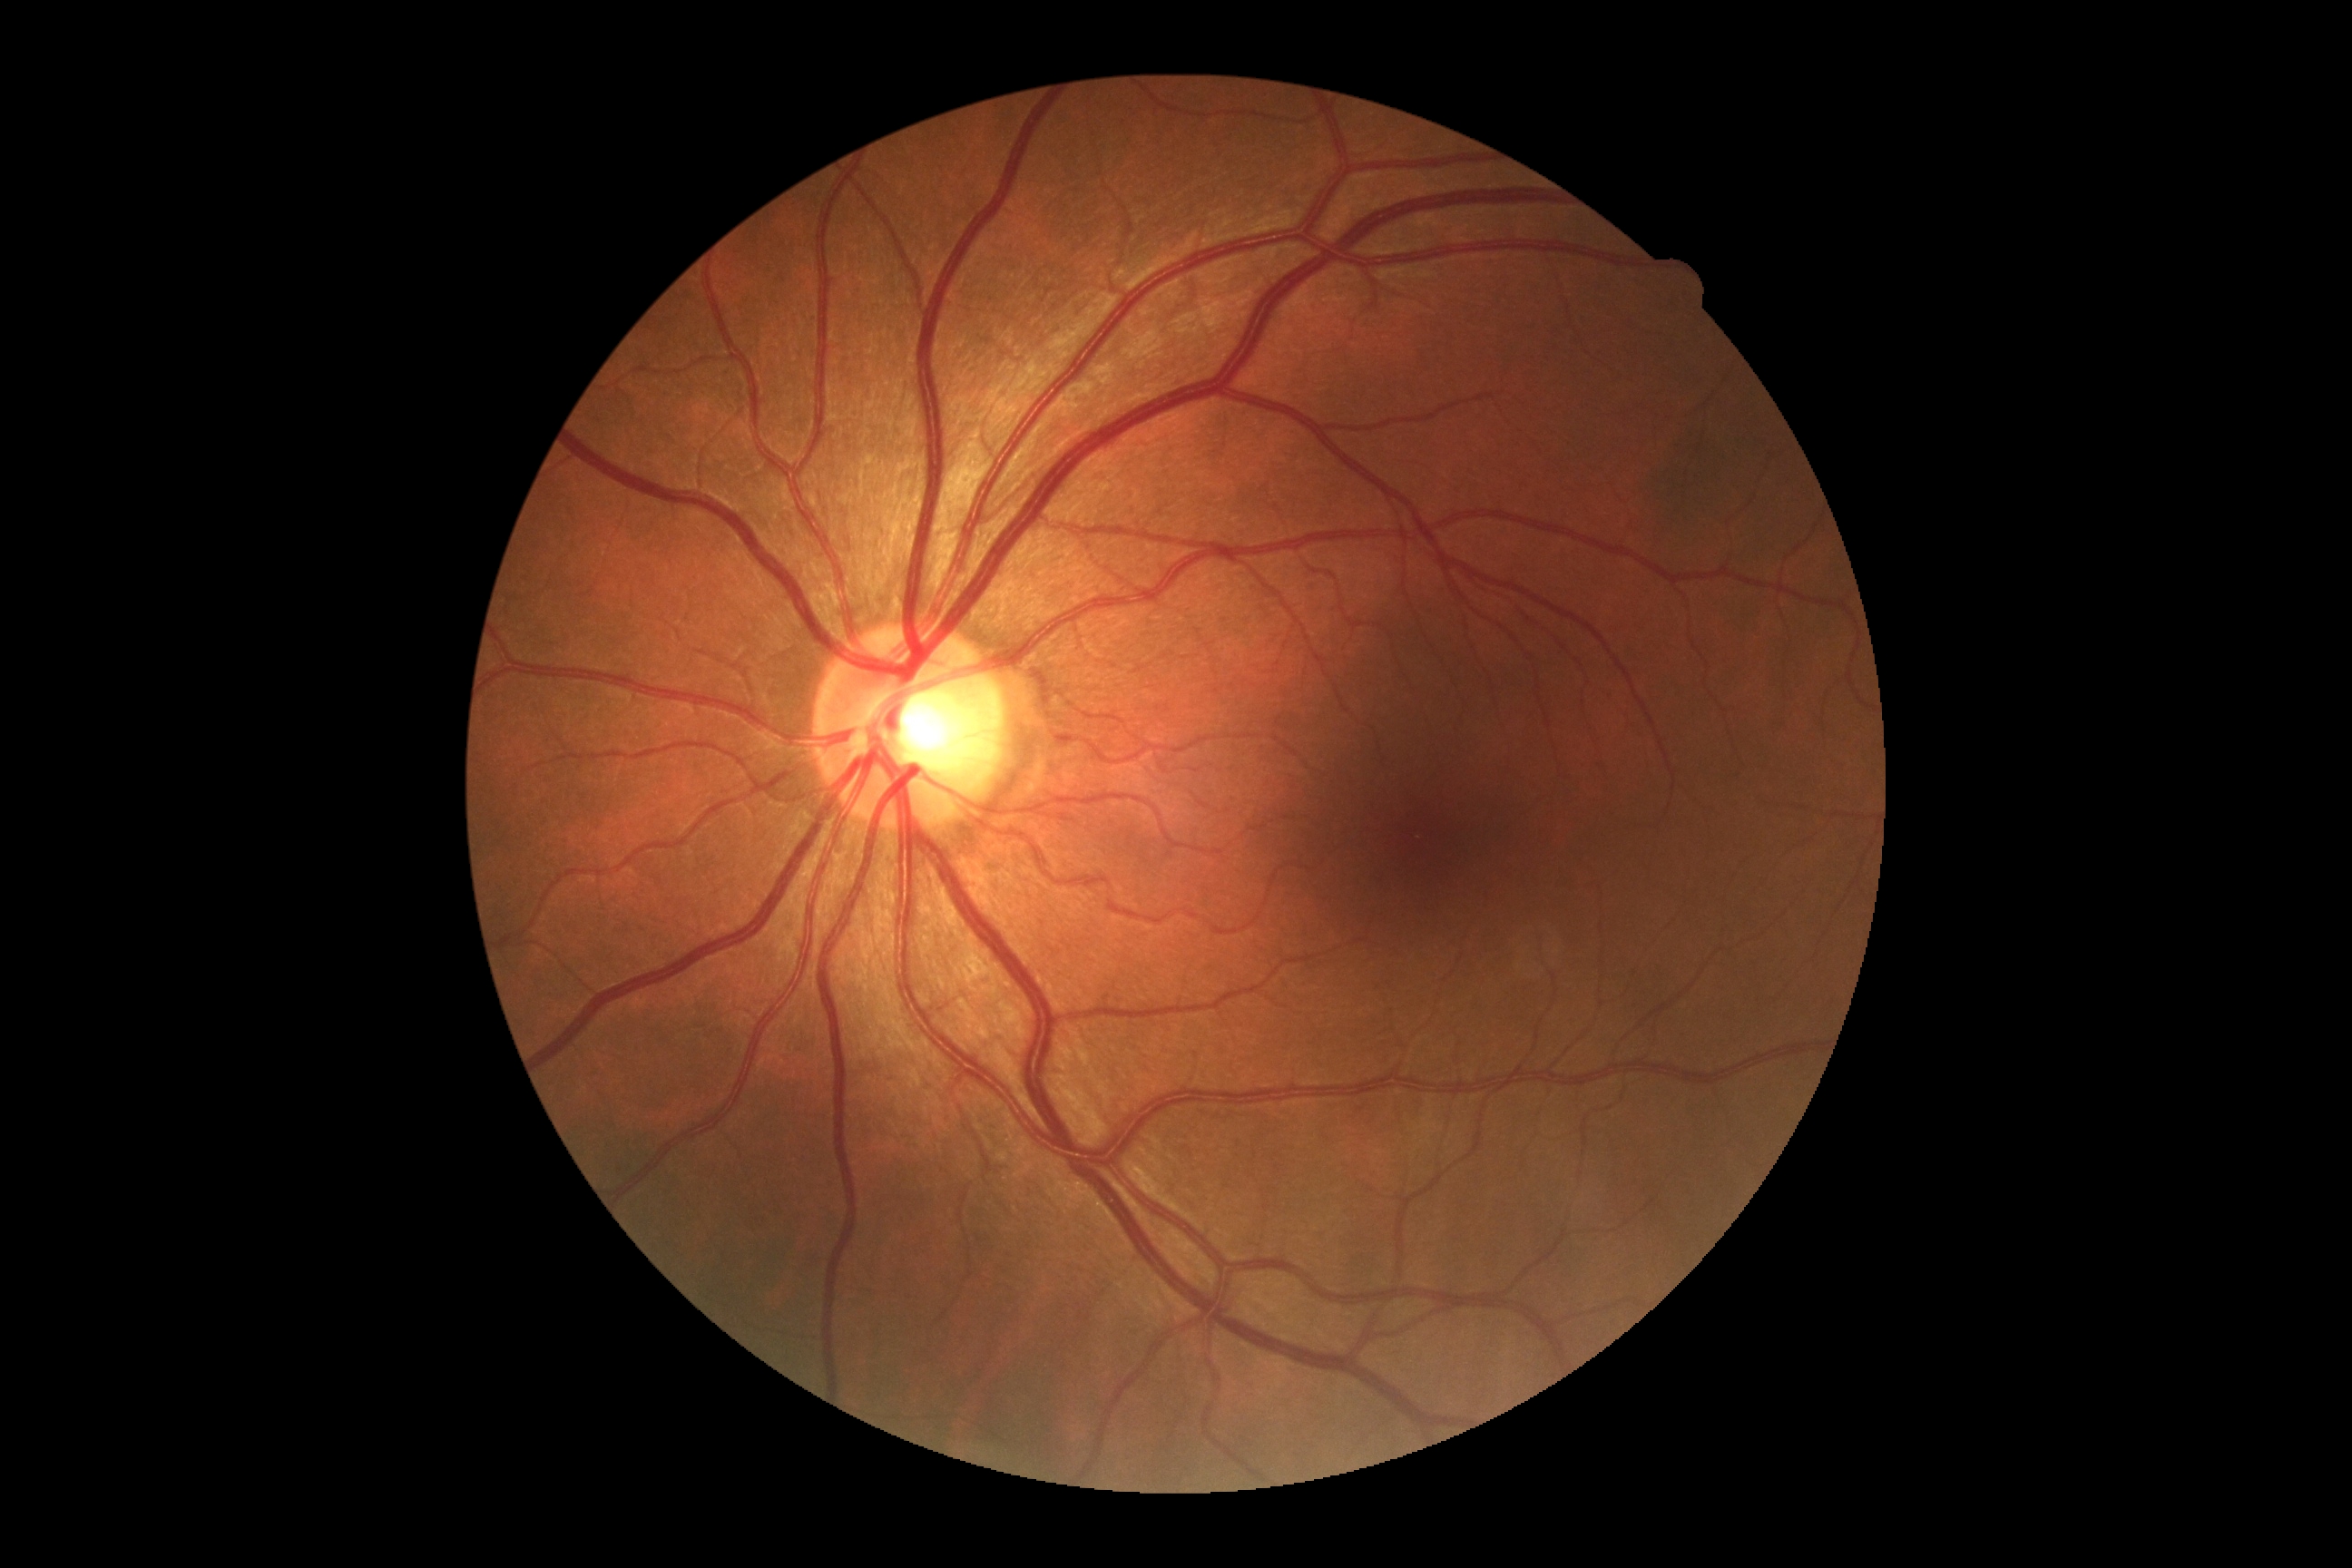
• retinopathy: 0